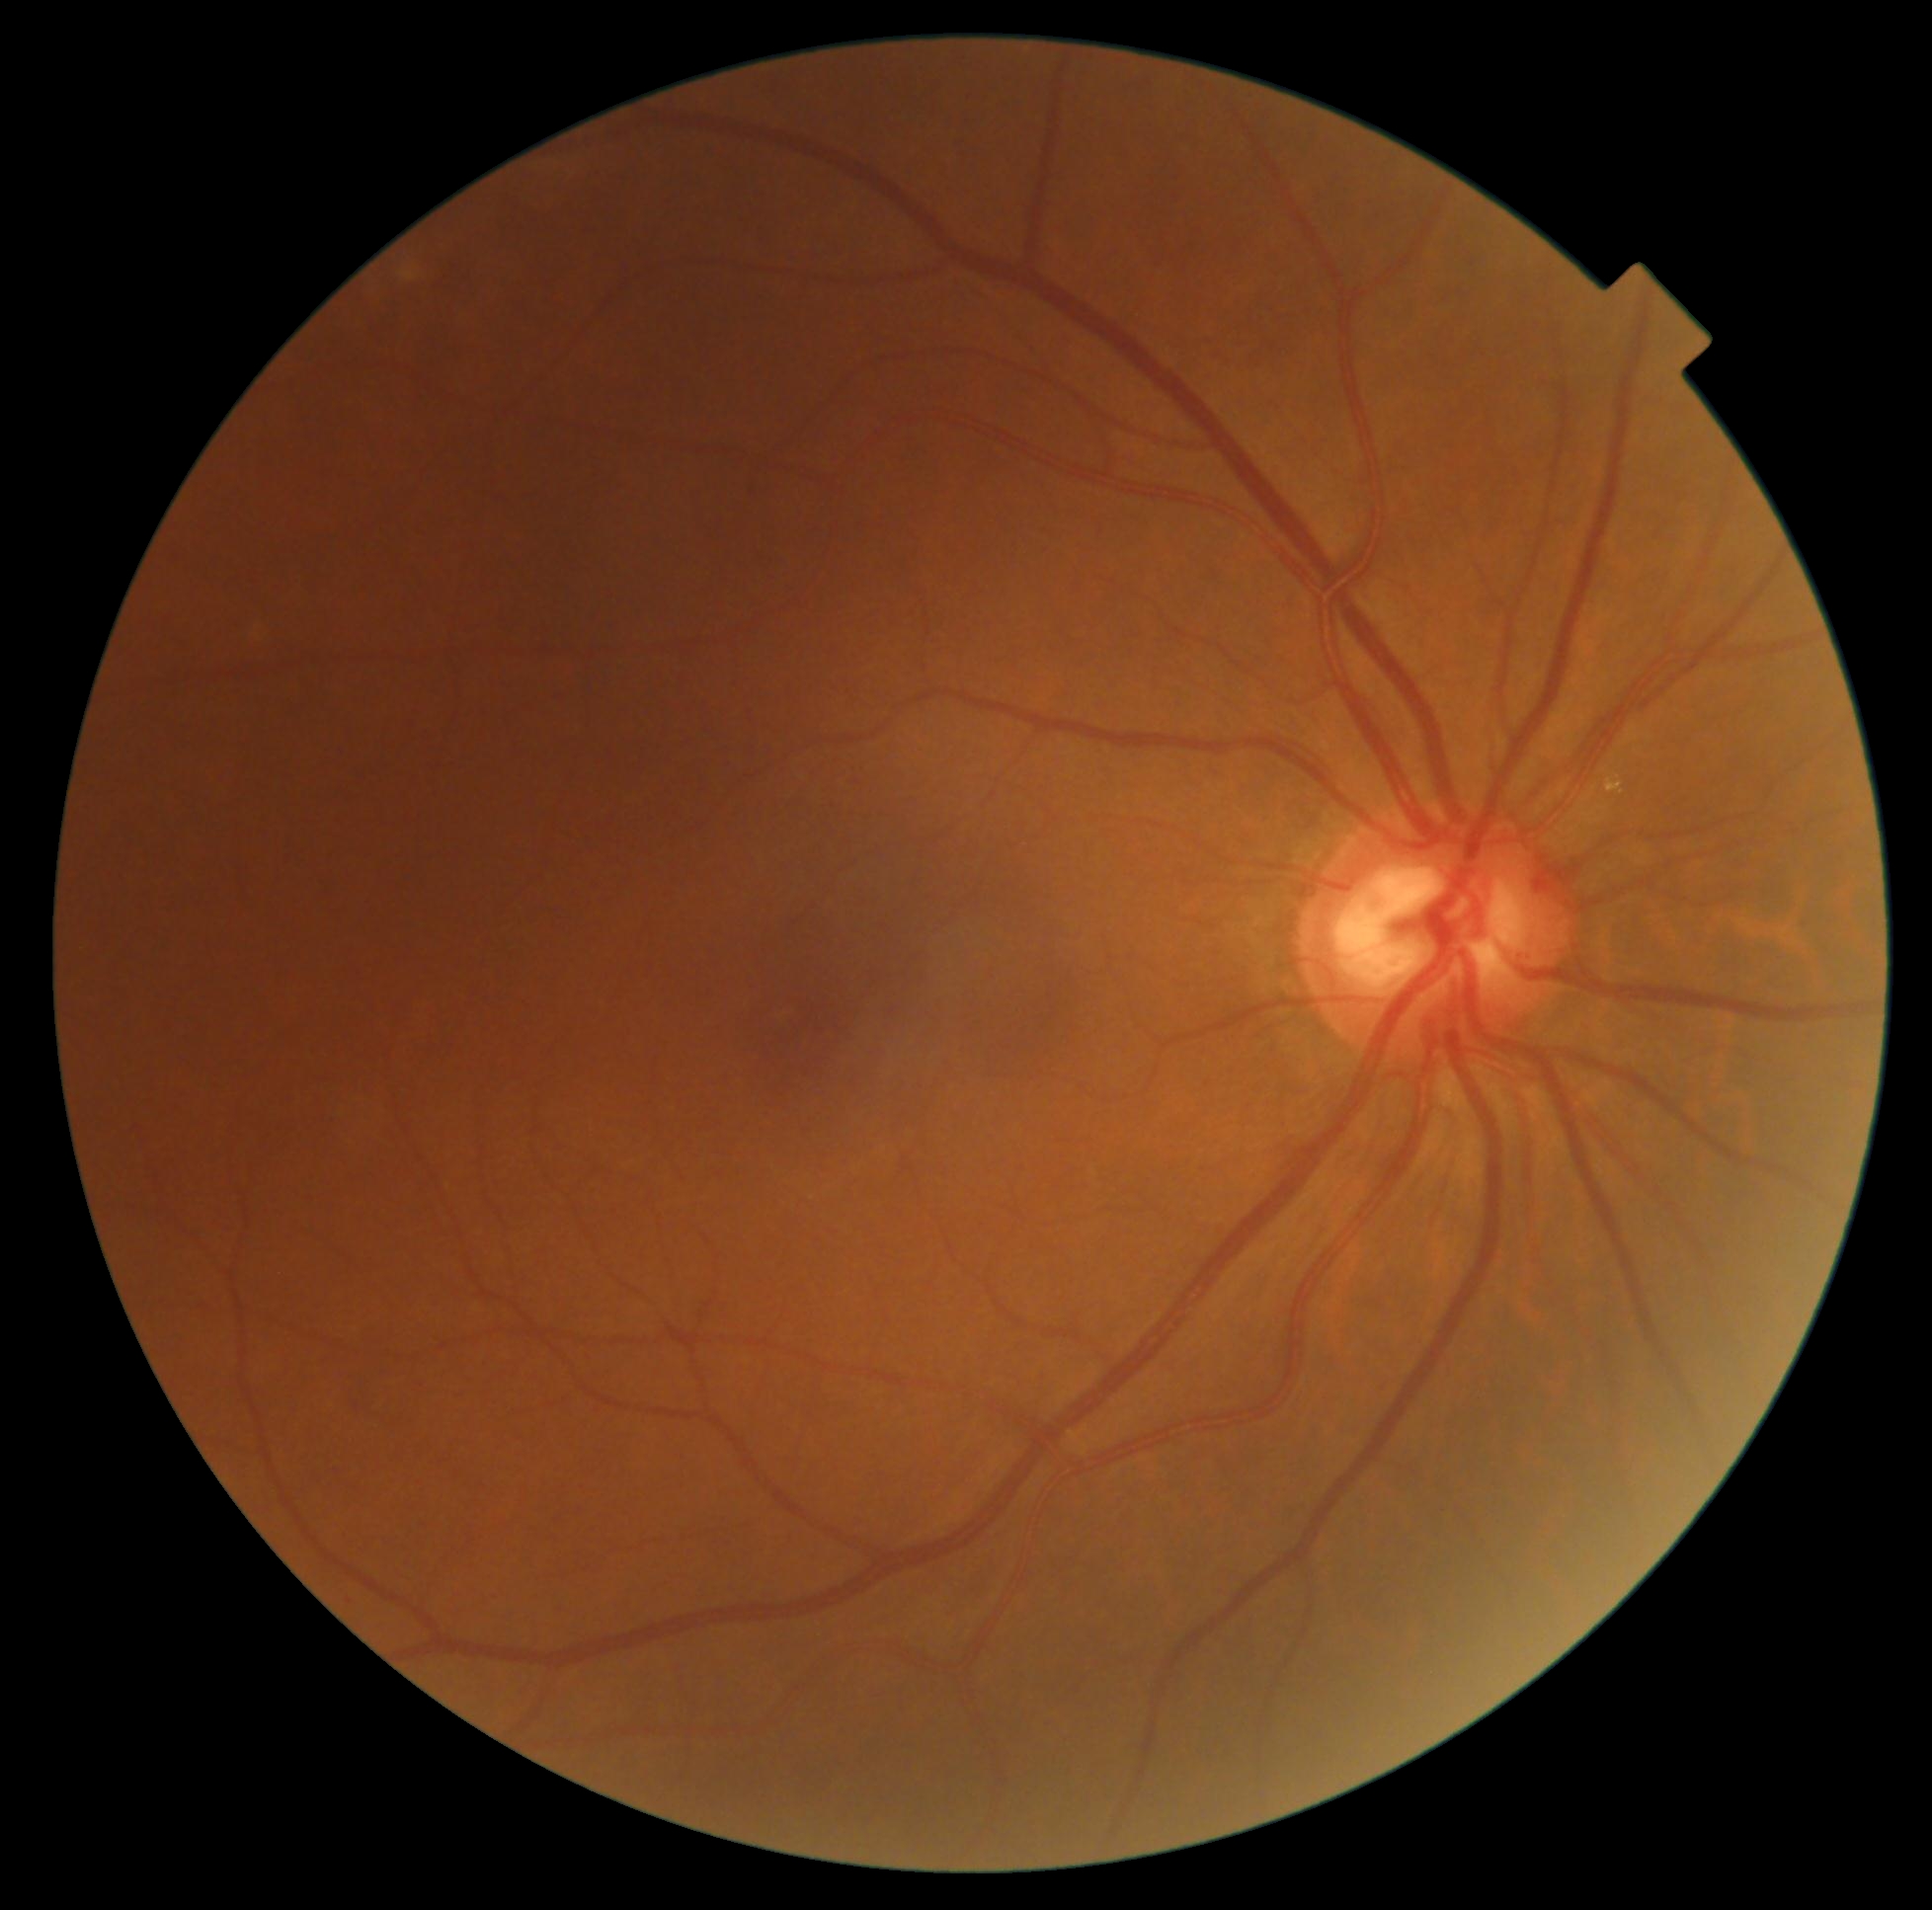

Diabetic retinopathy severity: no apparent retinopathy (grade 0).